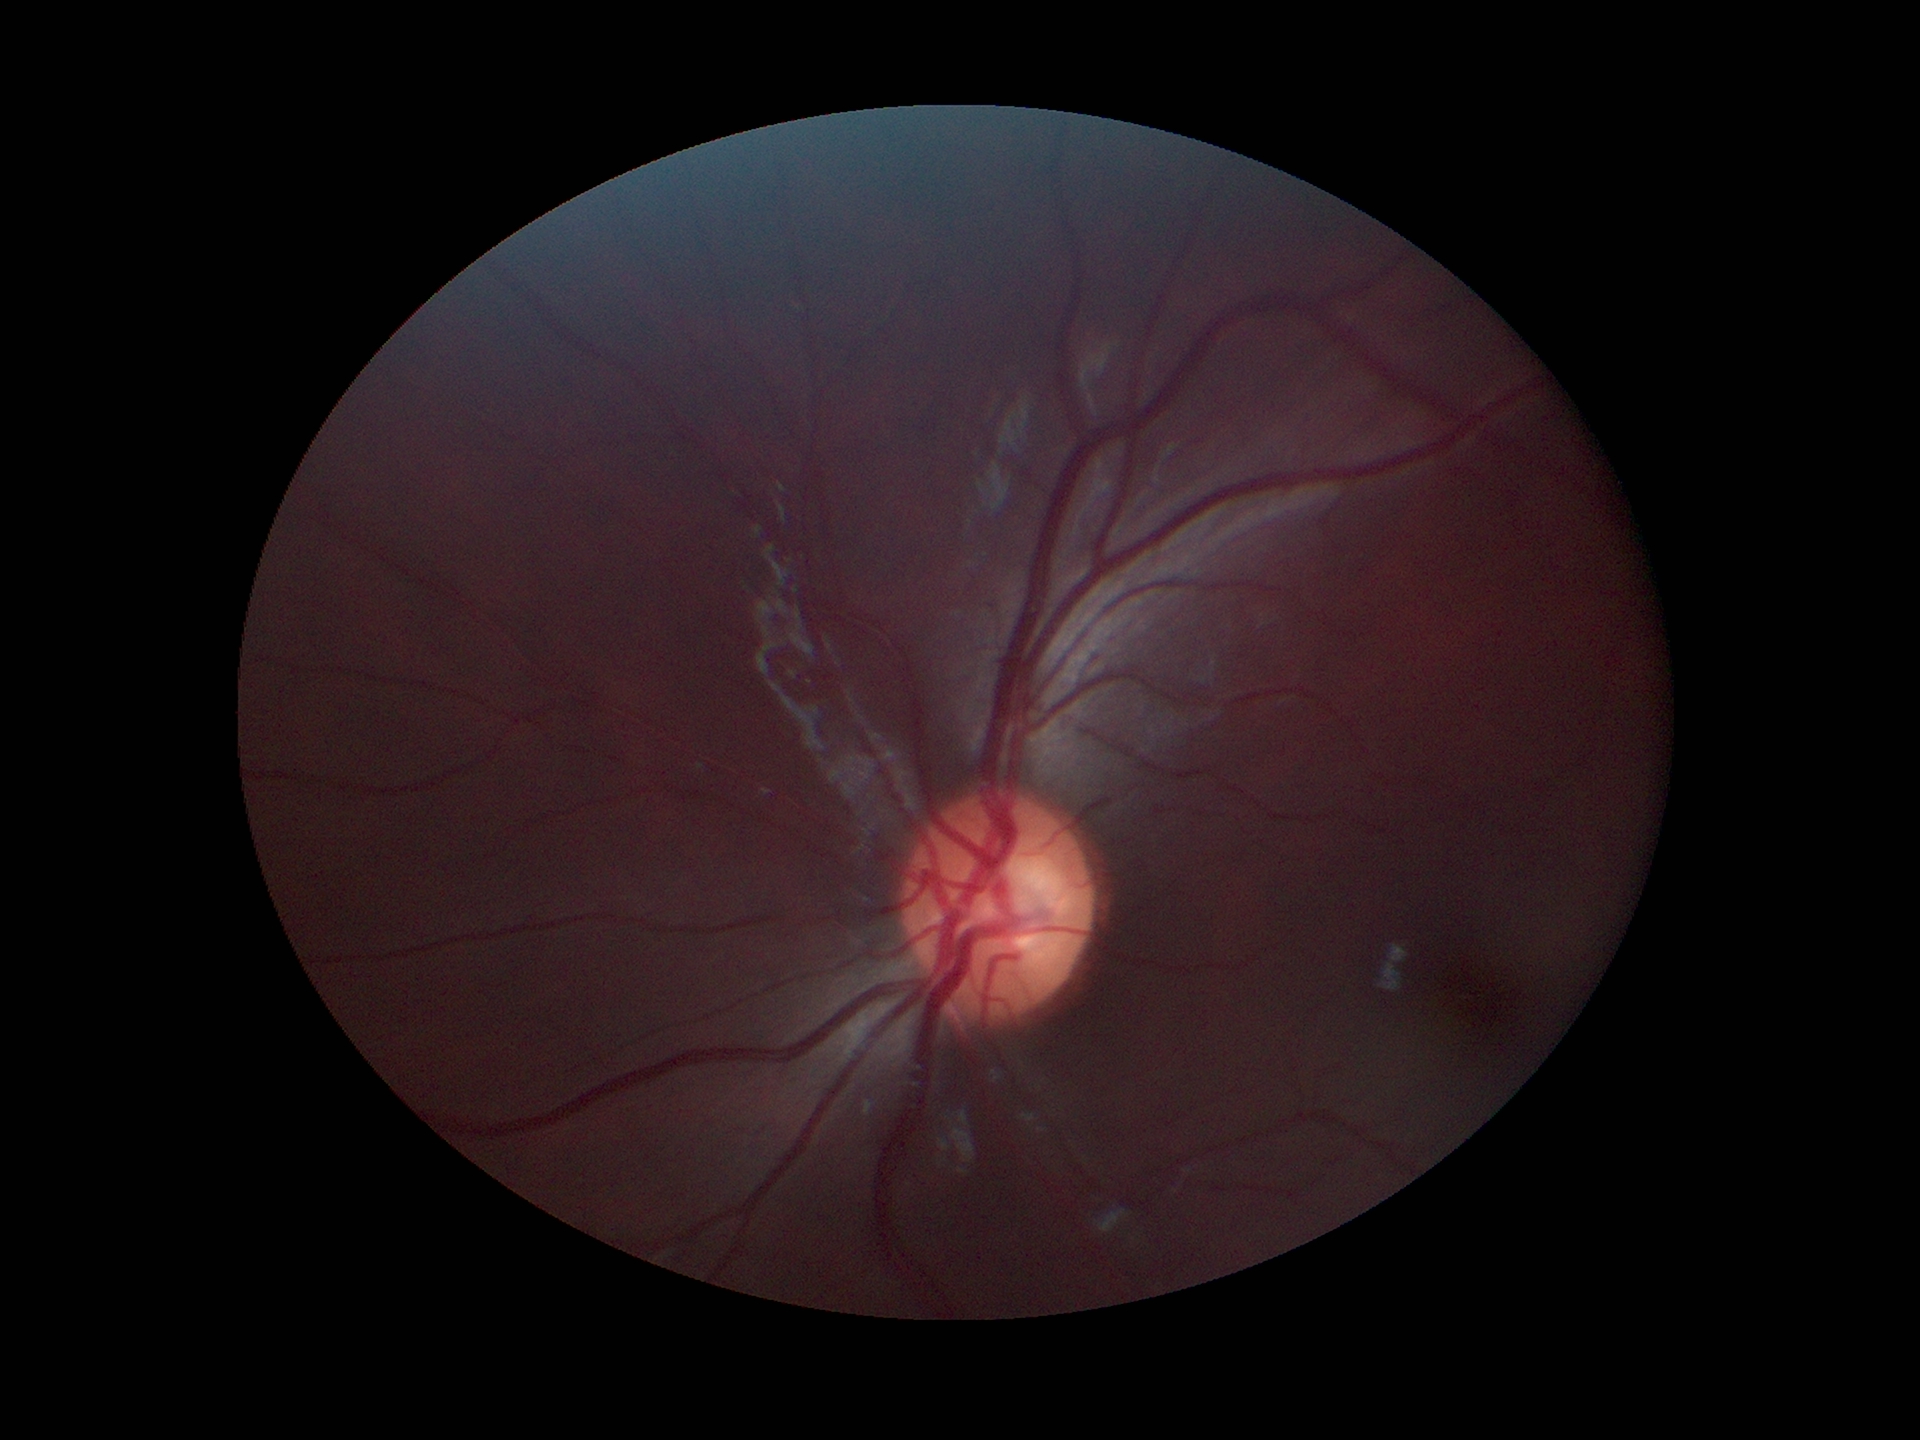

vertical CDR: 0.54; Glaucoma screening impression: not suspect